Wide-field fundus photograph from neonatal ROP screening.
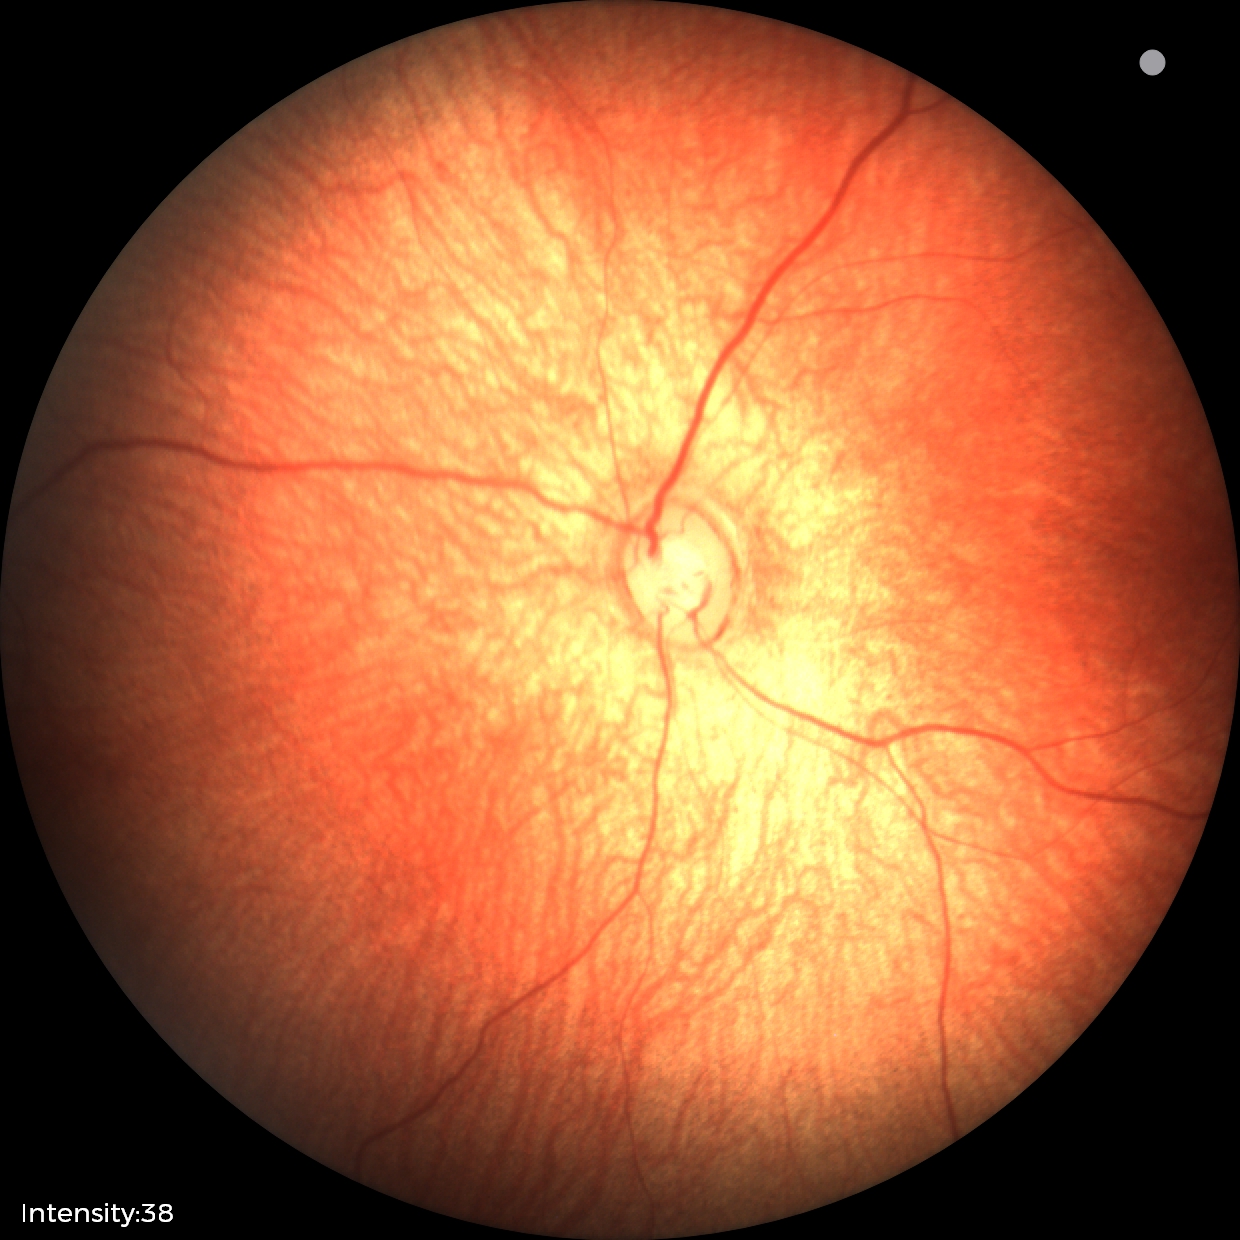

Examination with physiological retinal findings.